Captured on a Topcon TRC-NW8 fundus camera: 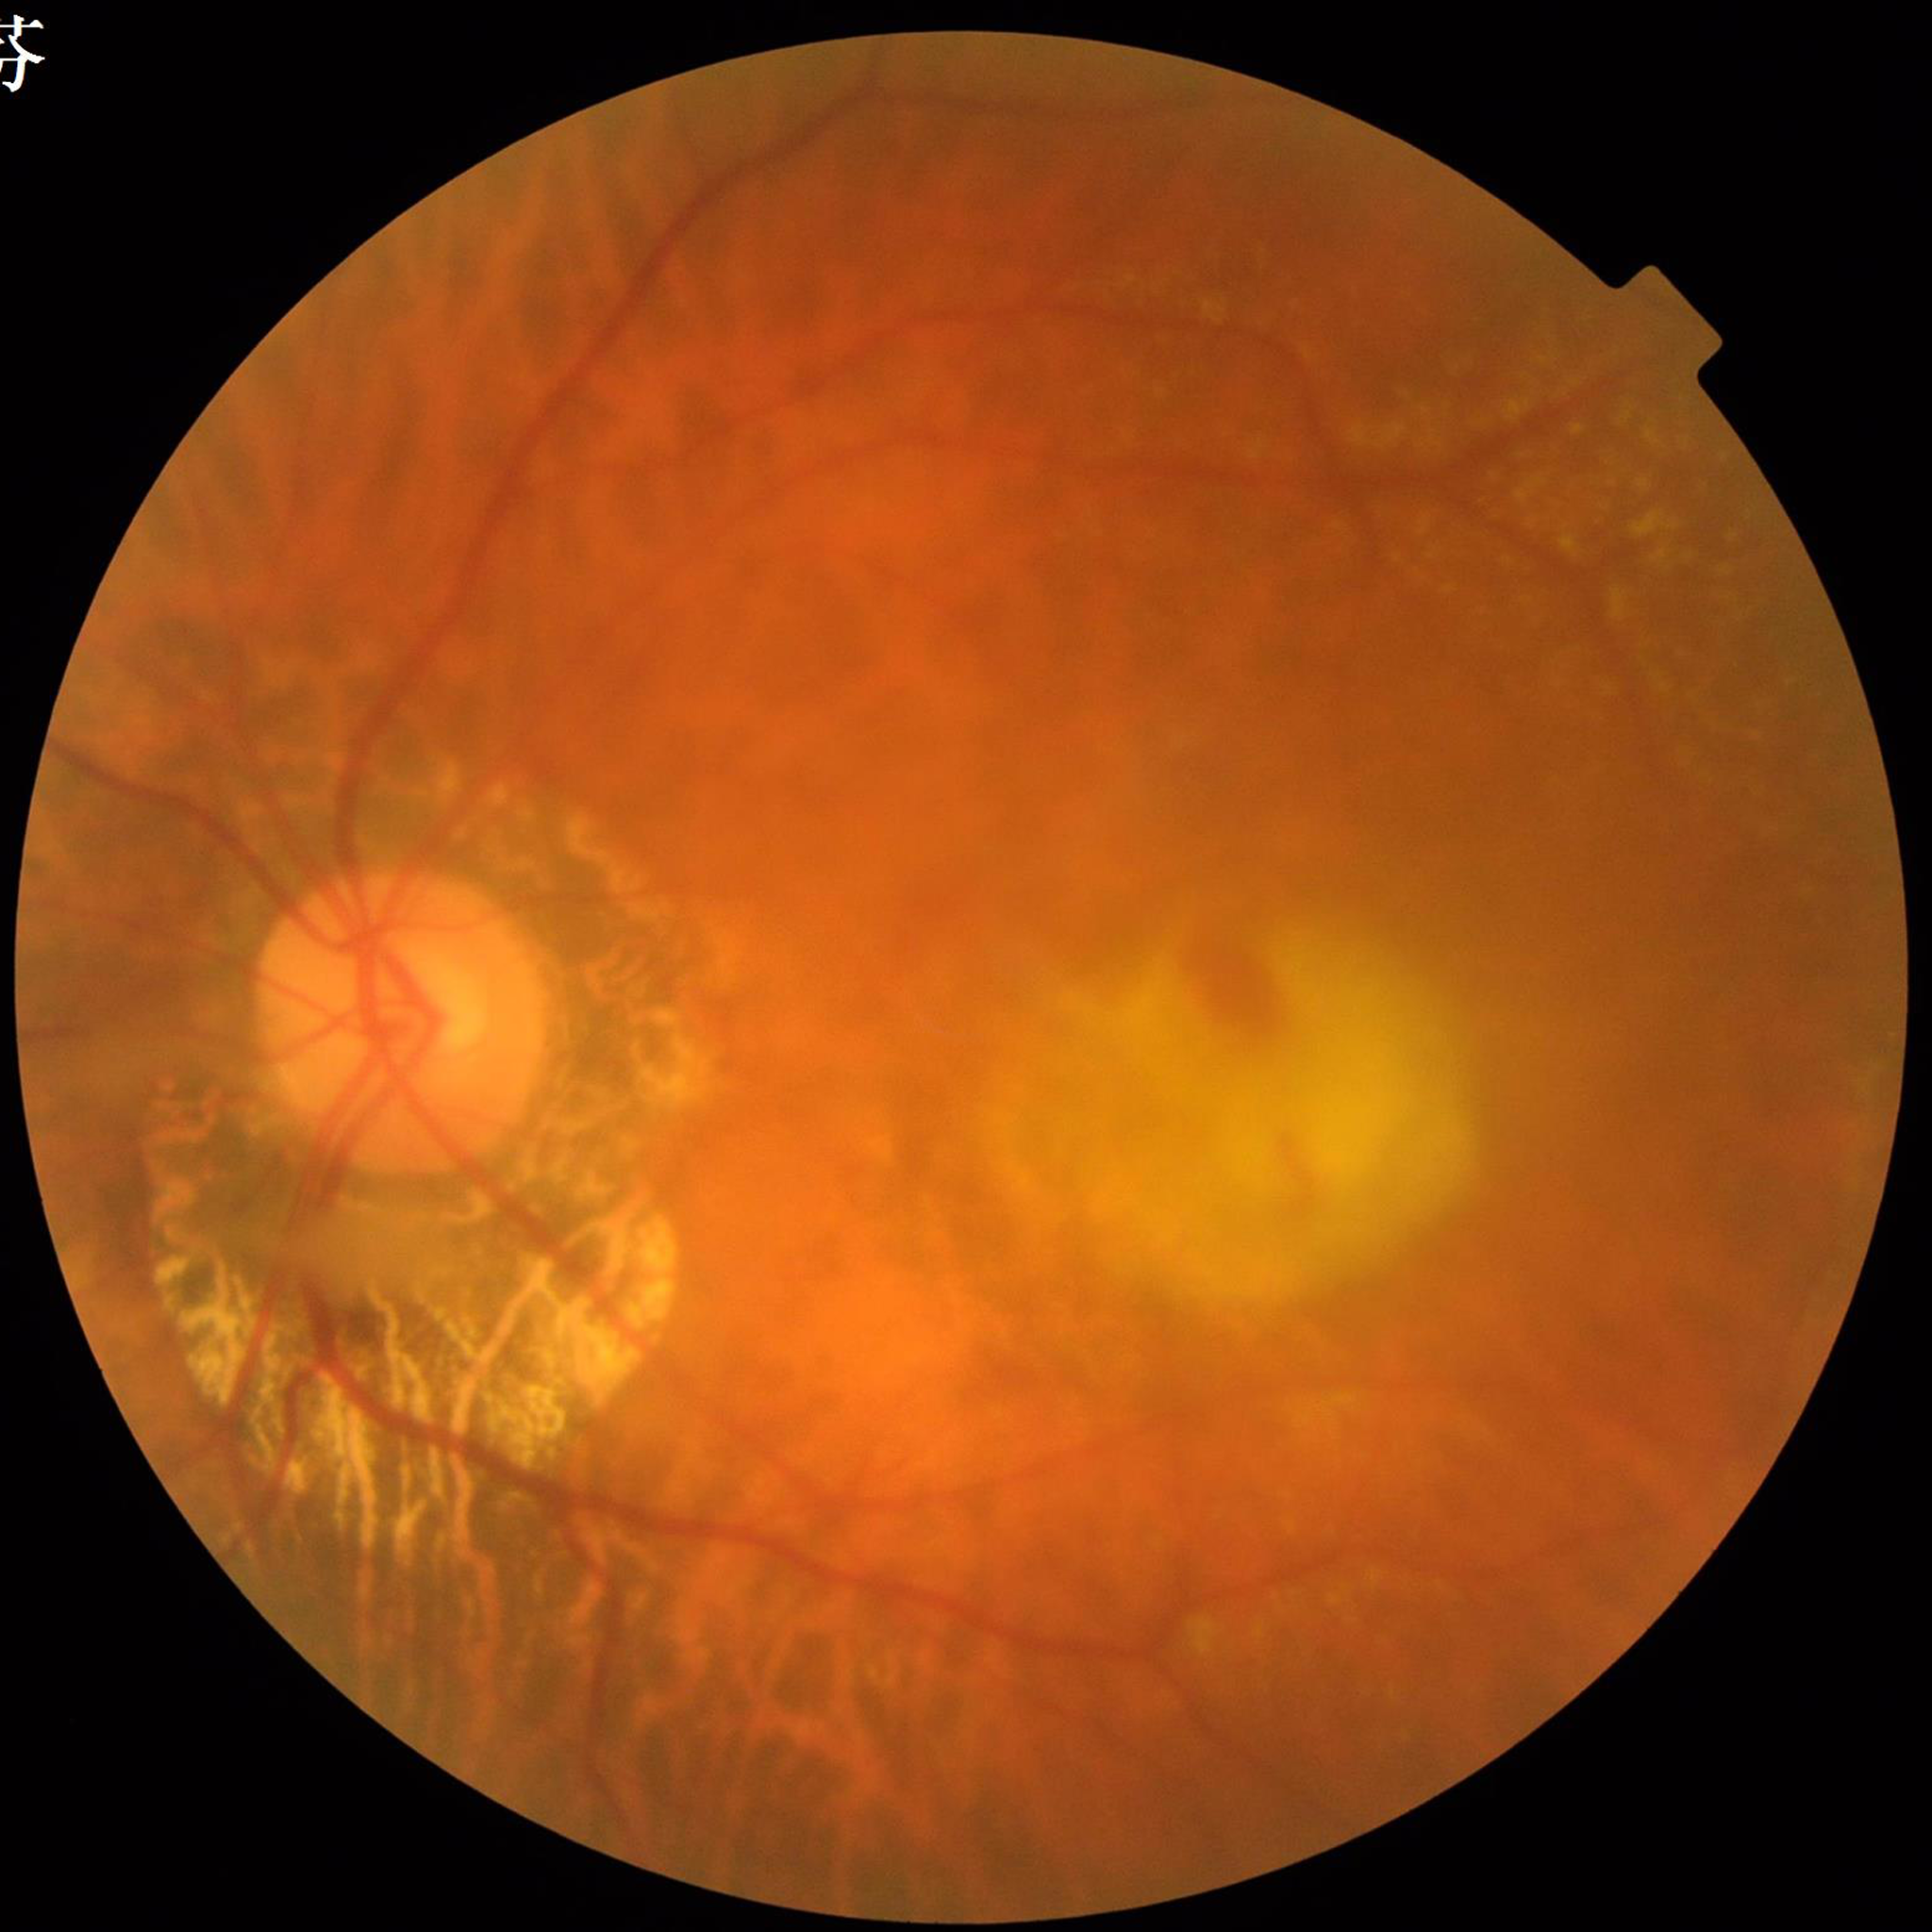
{"diagnosis": "AMD", "image_quality": "poor — blur"}